1240 x 1240 pixels. Captured with the Phoenix ICON (100° field of view). Wide-field fundus photograph of an infant
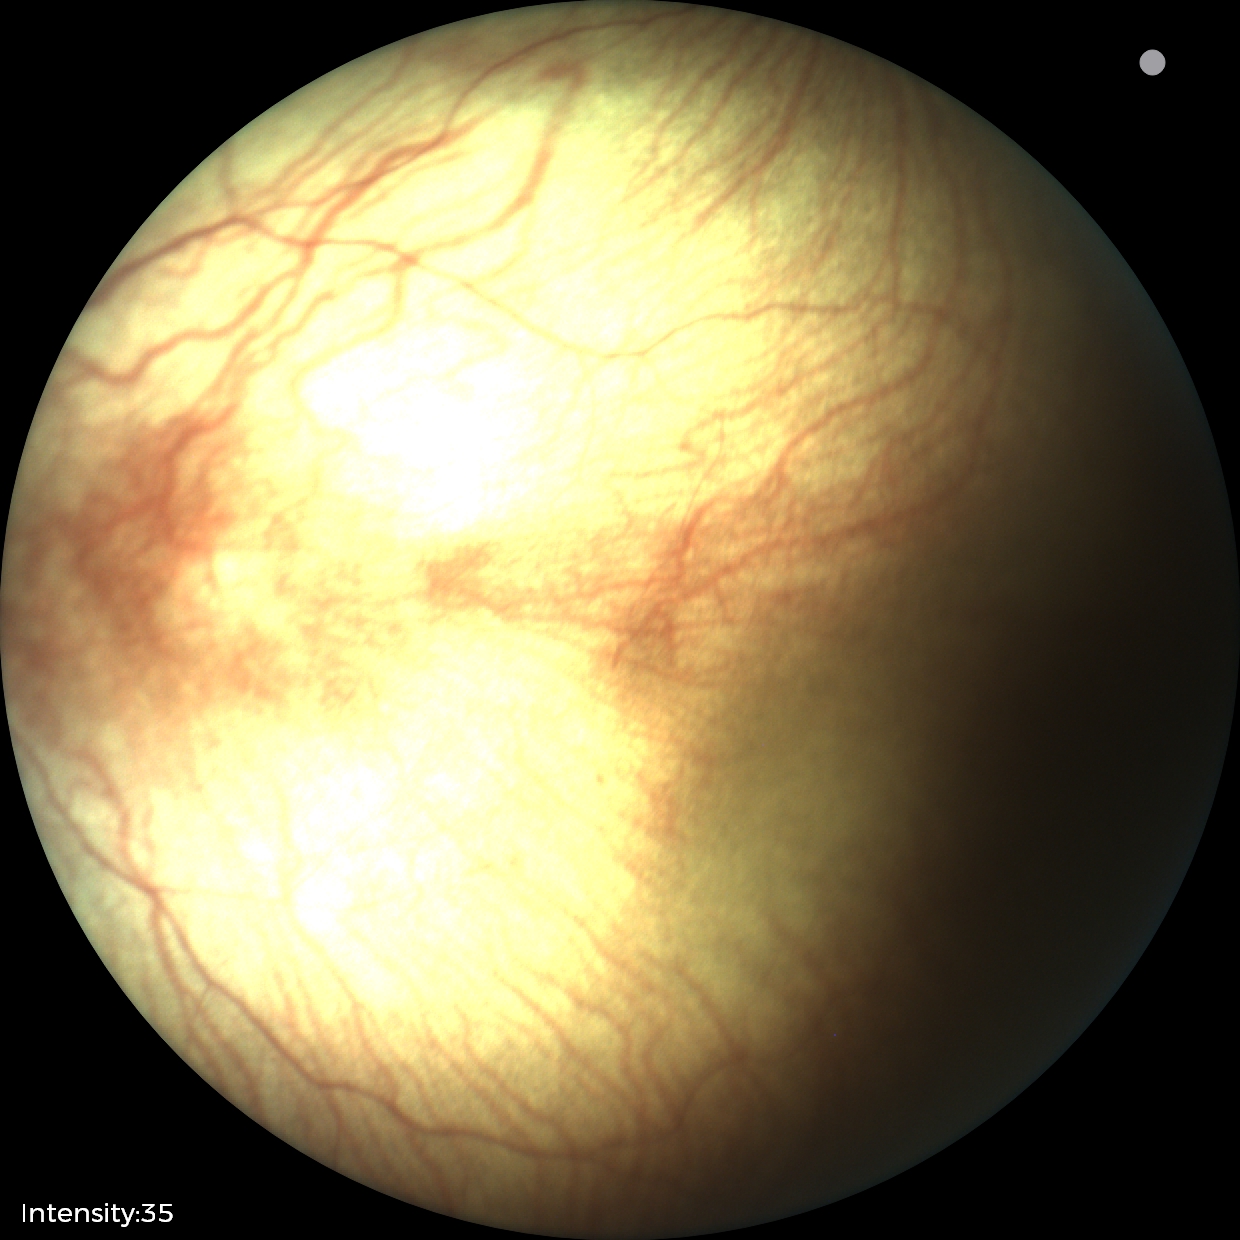

Screening examination with no abnormal retinal findings.